Color fundus photograph, 2352x1568px: 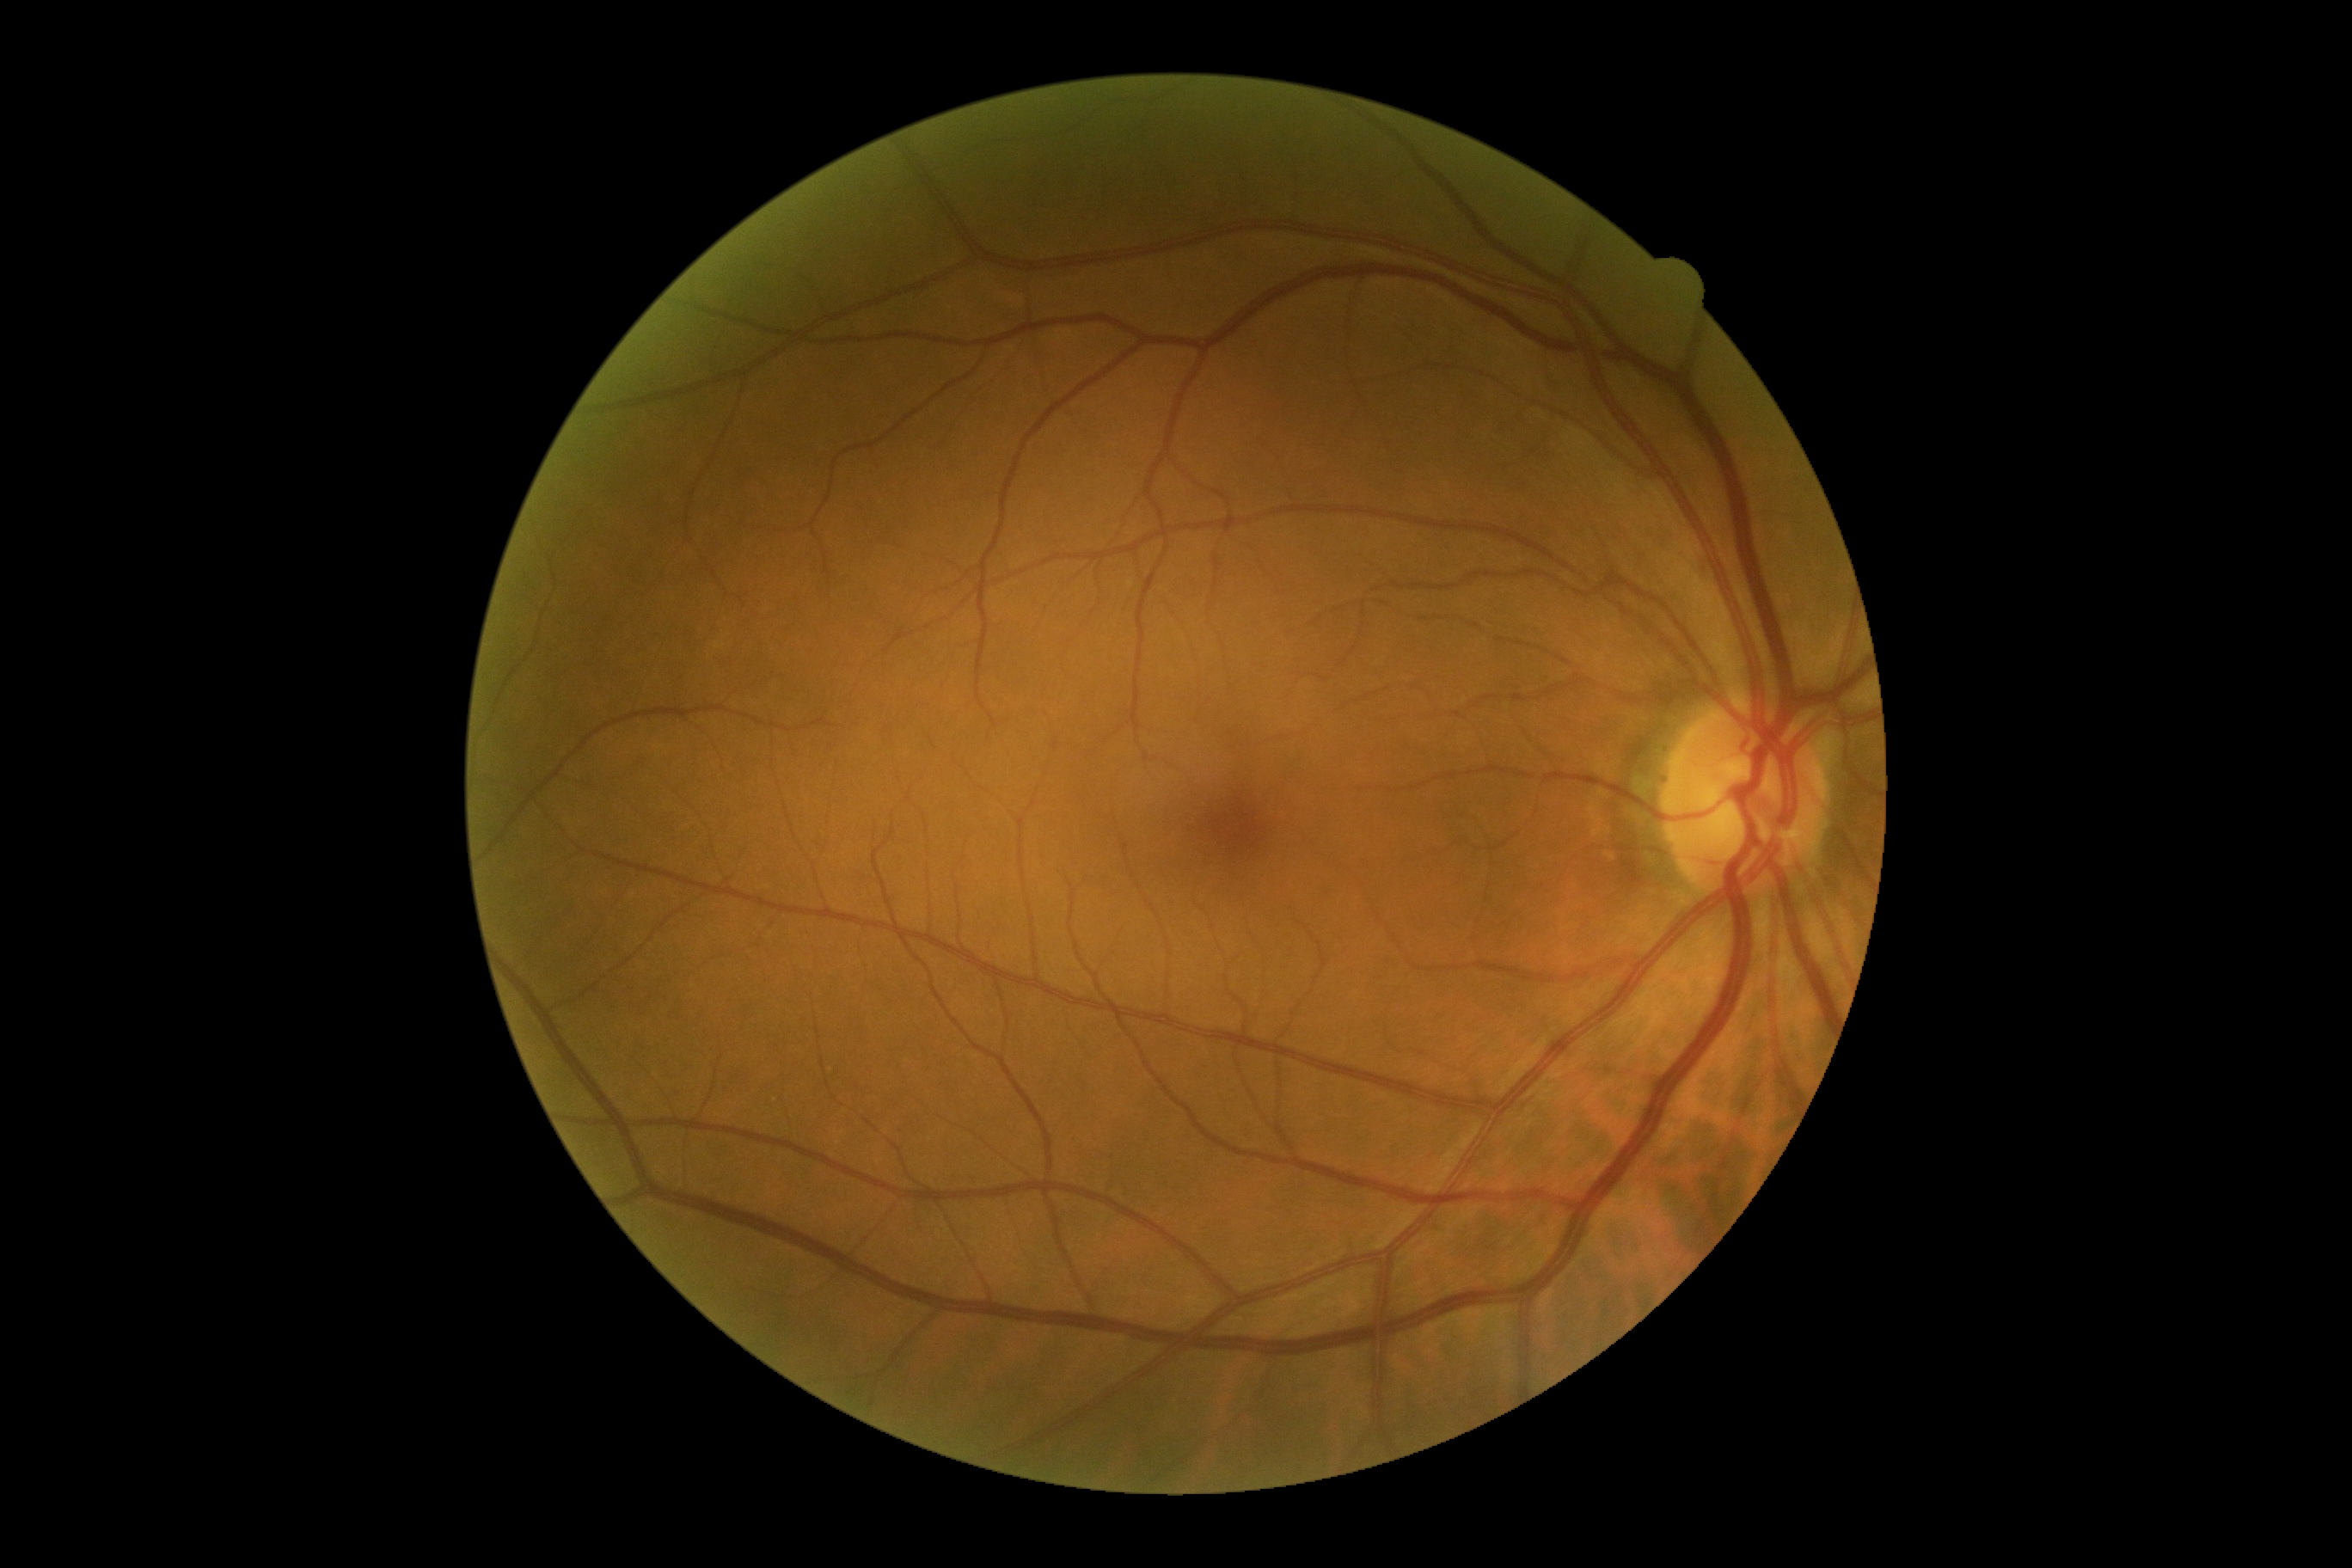
diabetic retinopathy: no apparent diabetic retinopathy (grade 0); DR impression: no apparent DR.